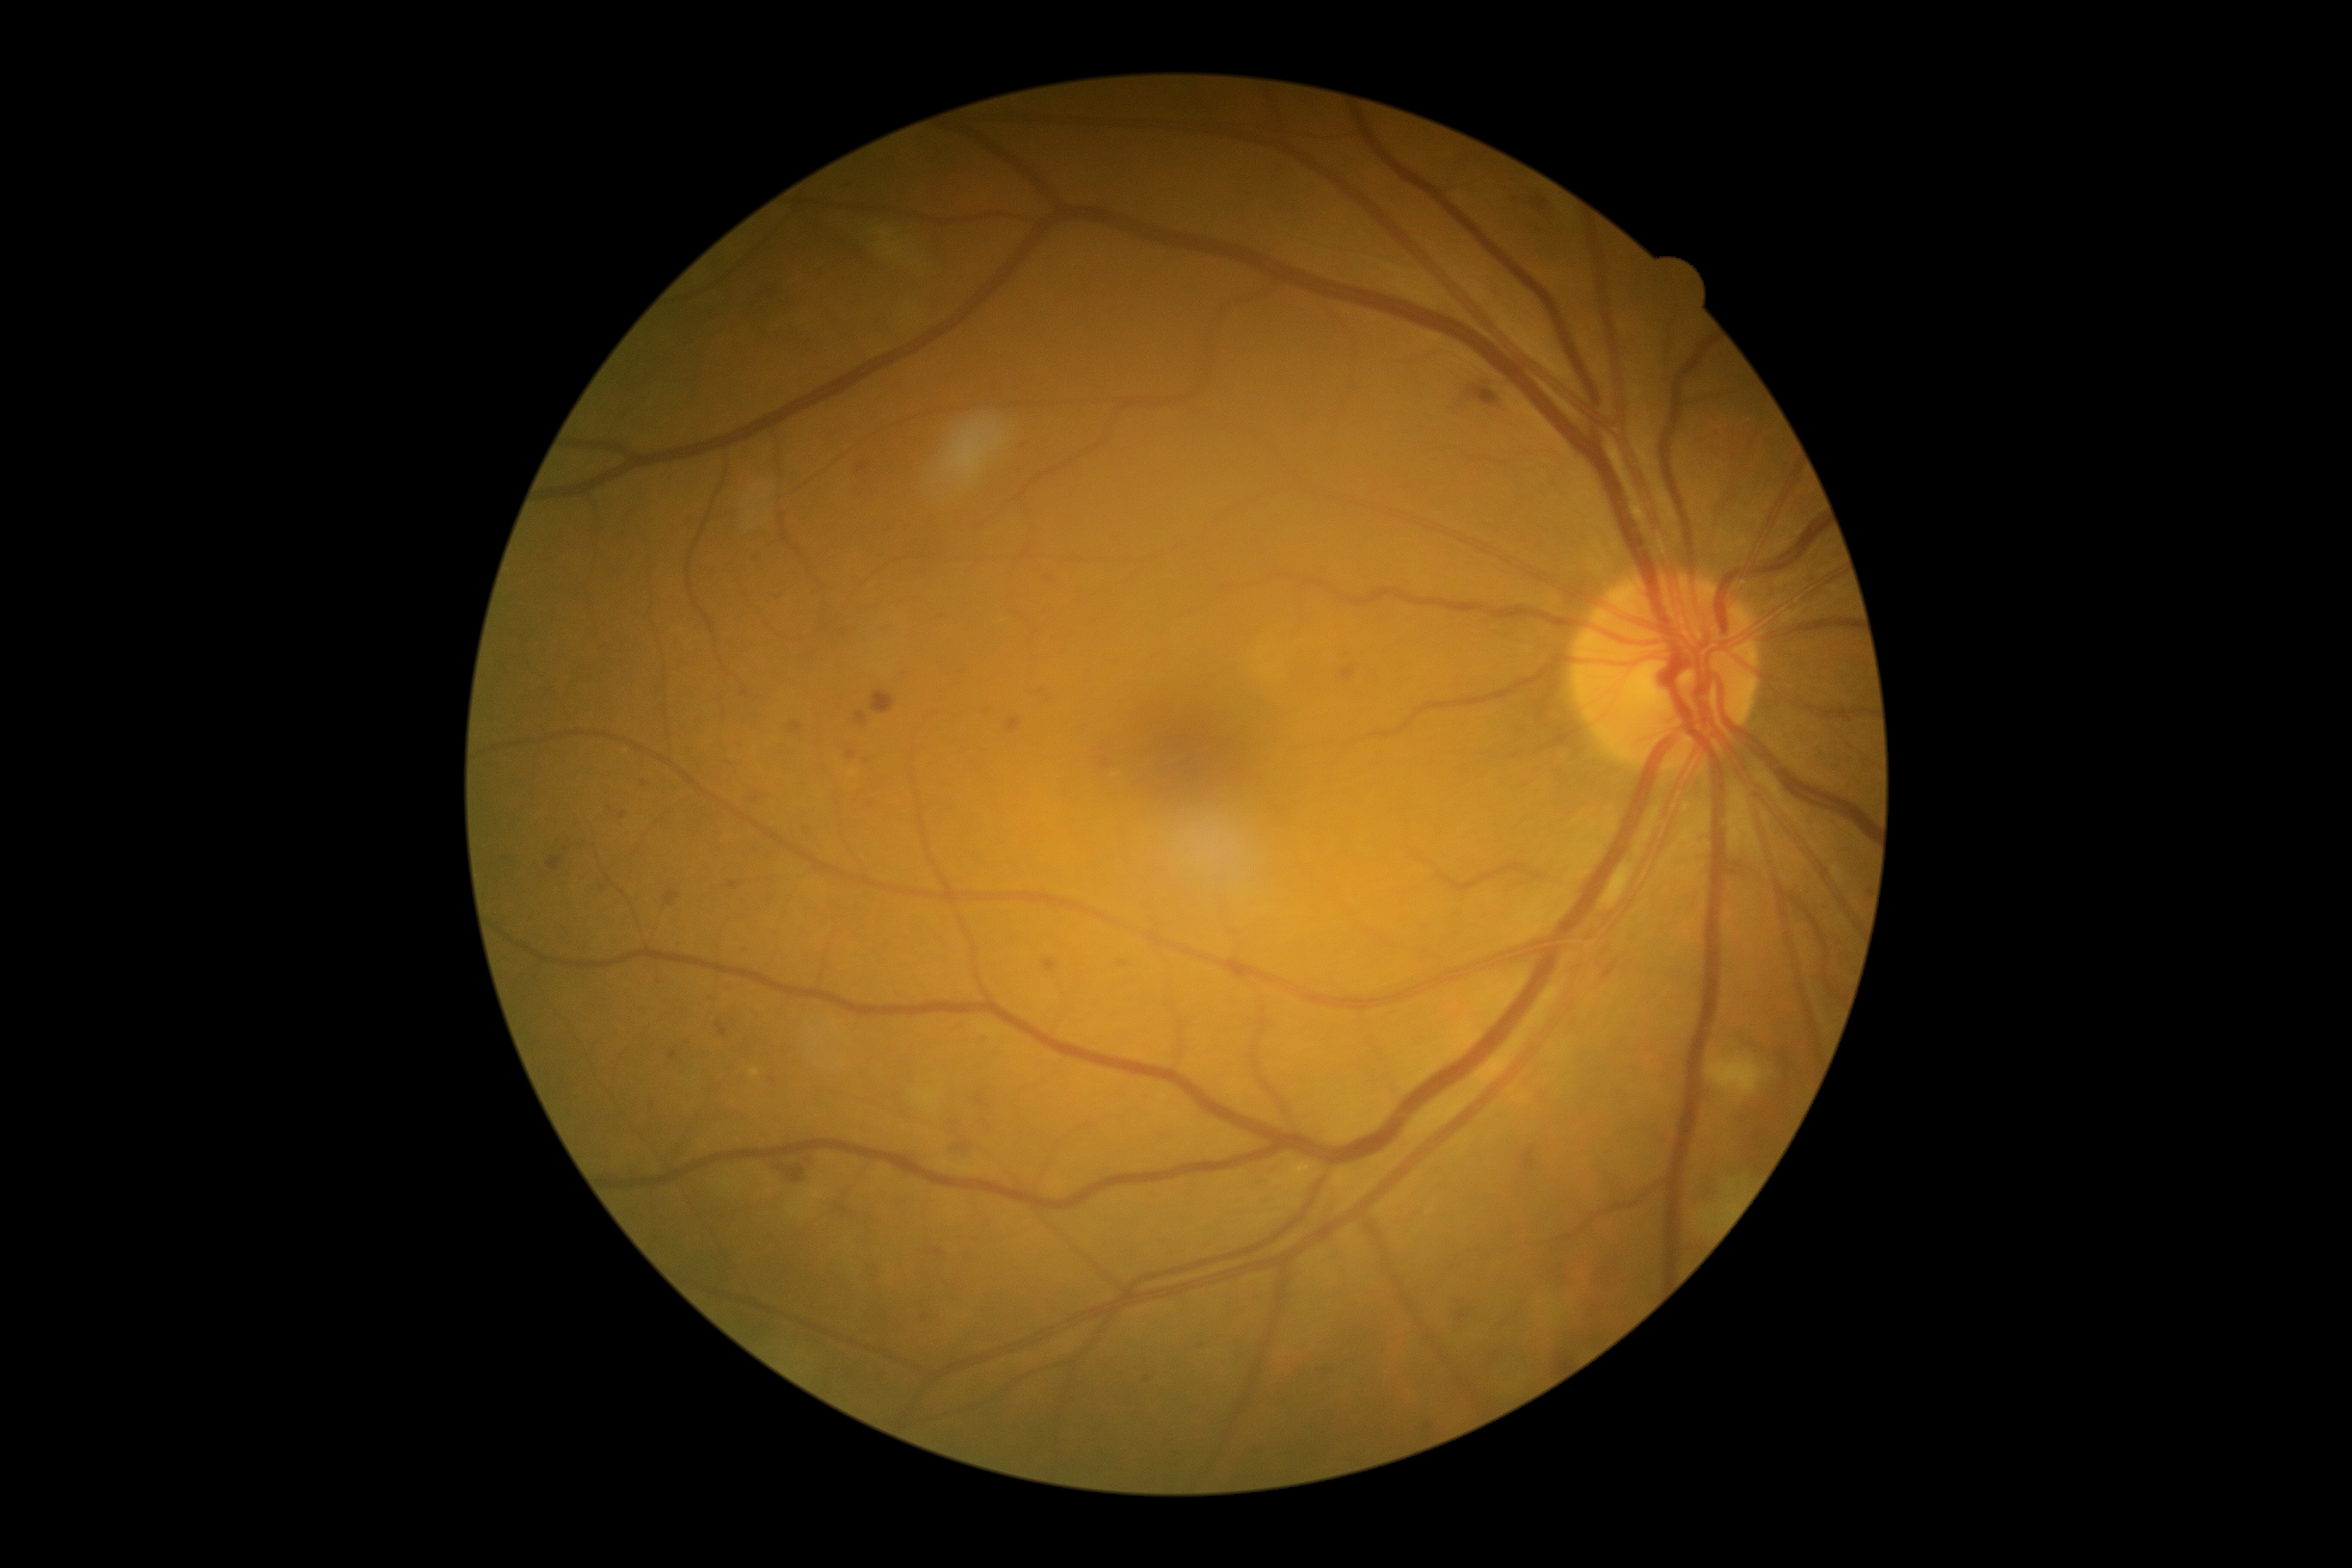
Diabetic retinopathy (DR): grade 2
A subset of detected lesions:
hemorrhages (HEs) = bbox=[1478, 391, 1497, 407], bbox=[1531, 197, 1550, 212], bbox=[871, 692, 897, 714], bbox=[778, 1167, 805, 1184]
hard exudates (EXs) = none detected
soft exudates (SEs) = bbox=[871, 226, 943, 279], bbox=[1708, 1055, 1768, 1105], bbox=[744, 474, 780, 520], bbox=[1602, 864, 1634, 909], bbox=[1706, 1165, 1760, 1232]
microaneurysms (MAs) (partial) = bbox=[728, 881, 740, 890], bbox=[1007, 720, 1020, 733], bbox=[1522, 1148, 1536, 1170], bbox=[836, 1208, 848, 1213], bbox=[670, 1051, 678, 1060], bbox=[1424, 1424, 1433, 1433], bbox=[1043, 959, 1058, 972], bbox=[622, 811, 627, 819], bbox=[1105, 757, 1108, 768], bbox=[977, 1036, 989, 1046], bbox=[790, 721, 802, 733]
Smaller MAs around (806; 829), (644; 783), (730; 764), (726; 992)